45° FOV. 2048x1536px: 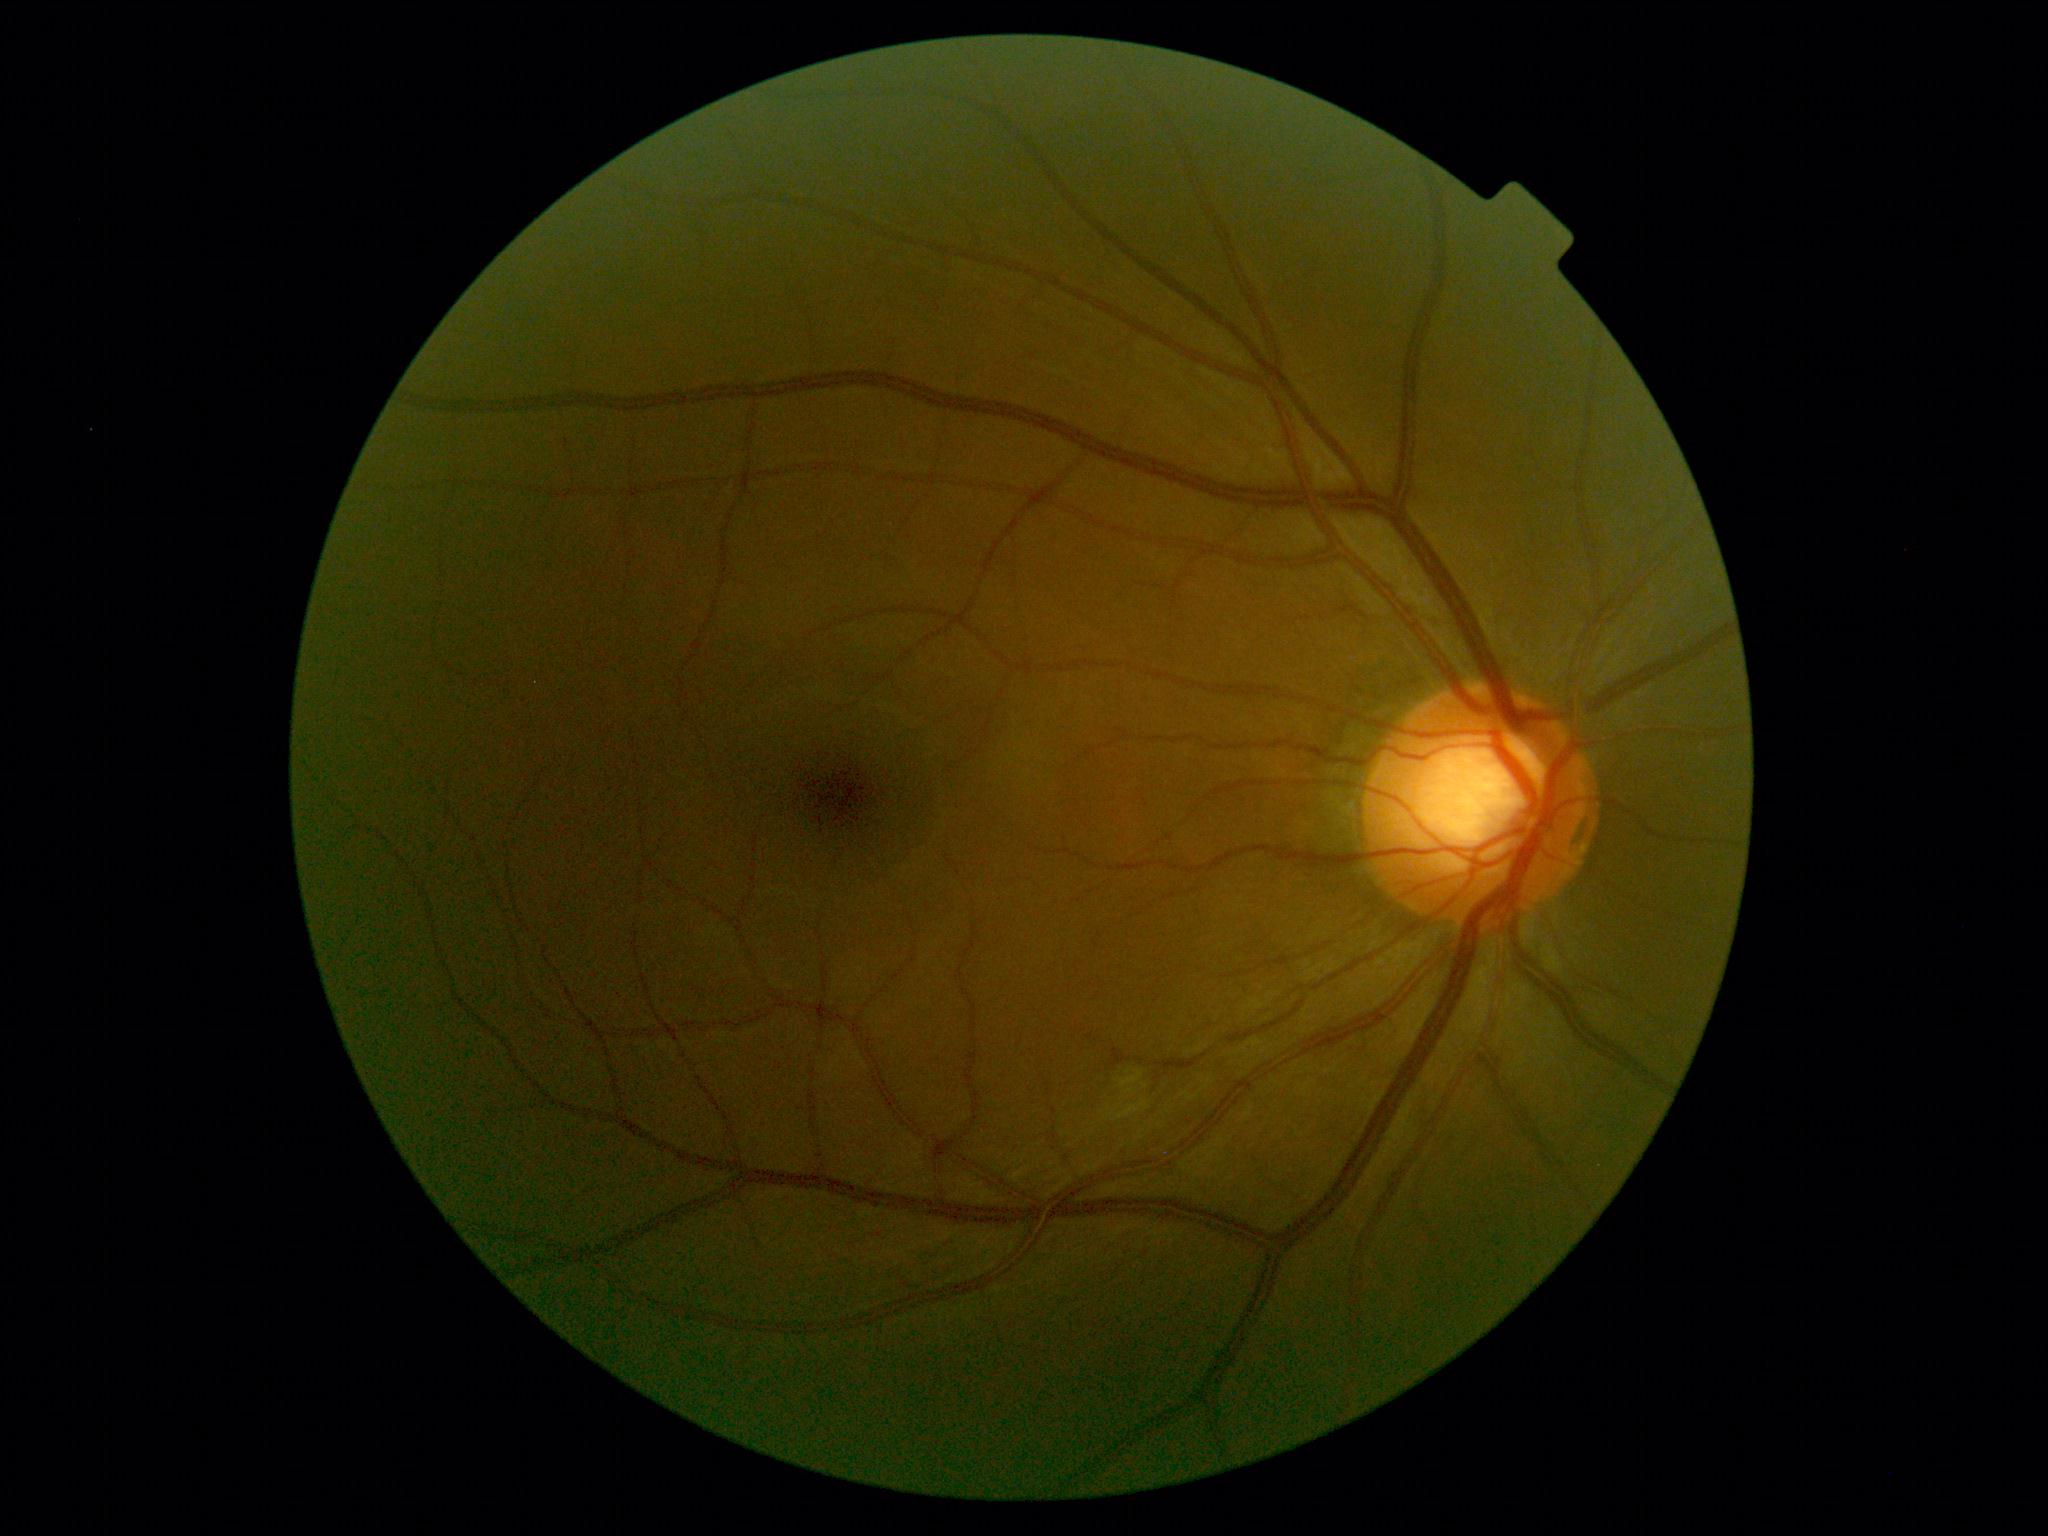

DR grade: 2.